Modified Davis classification
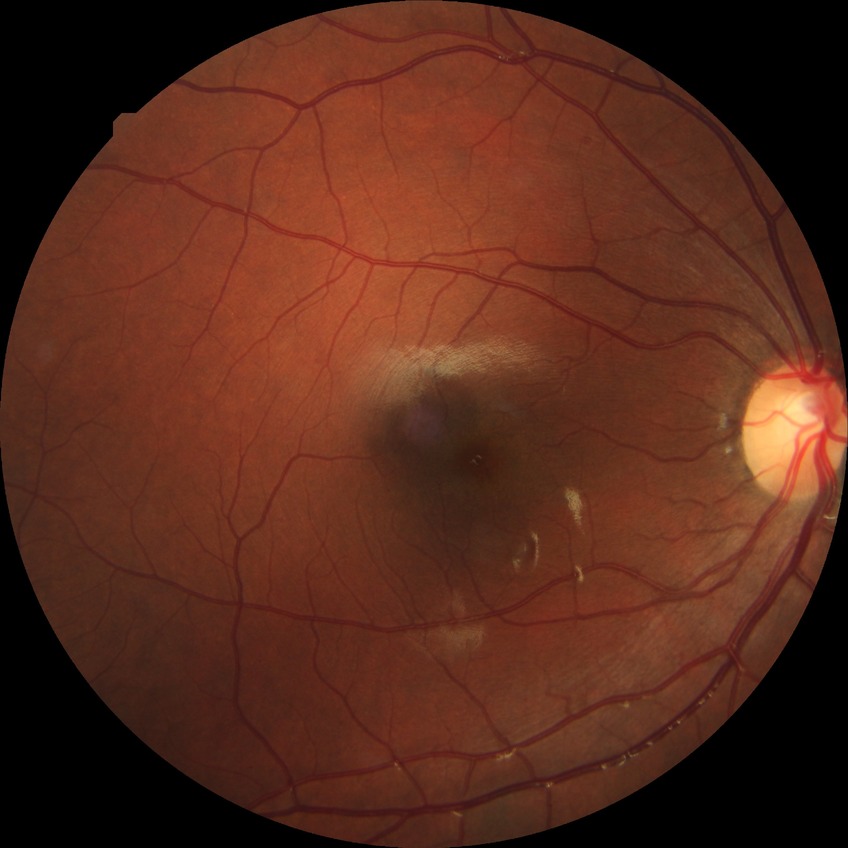

Diabetic retinopathy (DR) is no diabetic retinopathy (NDR).